Without pupil dilation. Image size 848x848. FOV: 45 degrees:
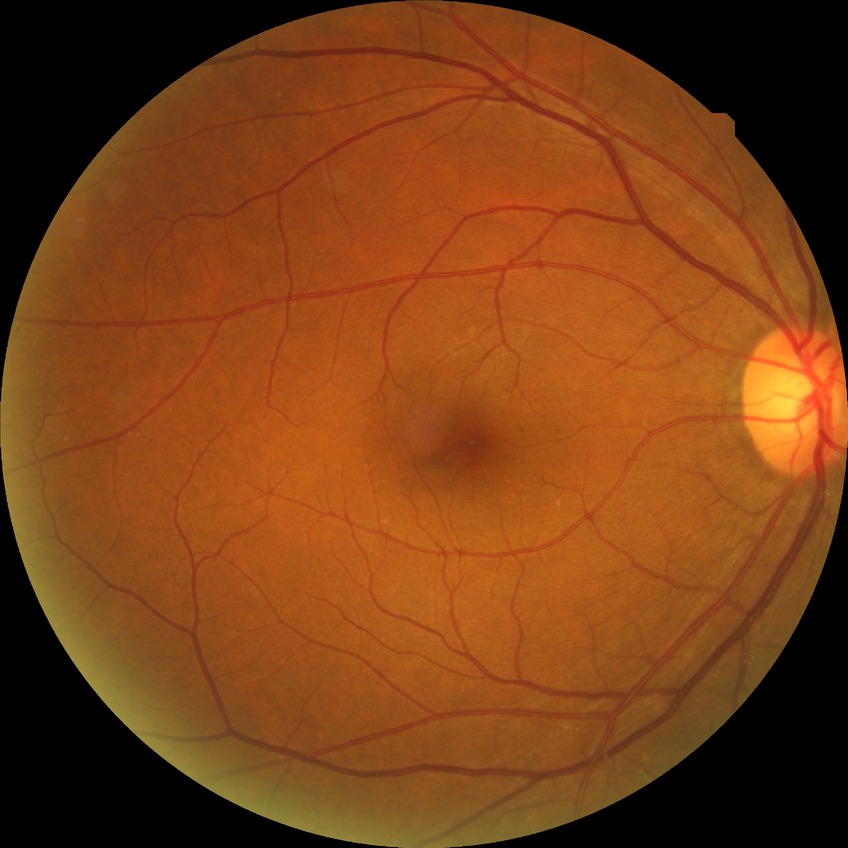 diabetic retinopathy (DR) = simple diabetic retinopathy (SDR).